2352 by 1568 pixels.
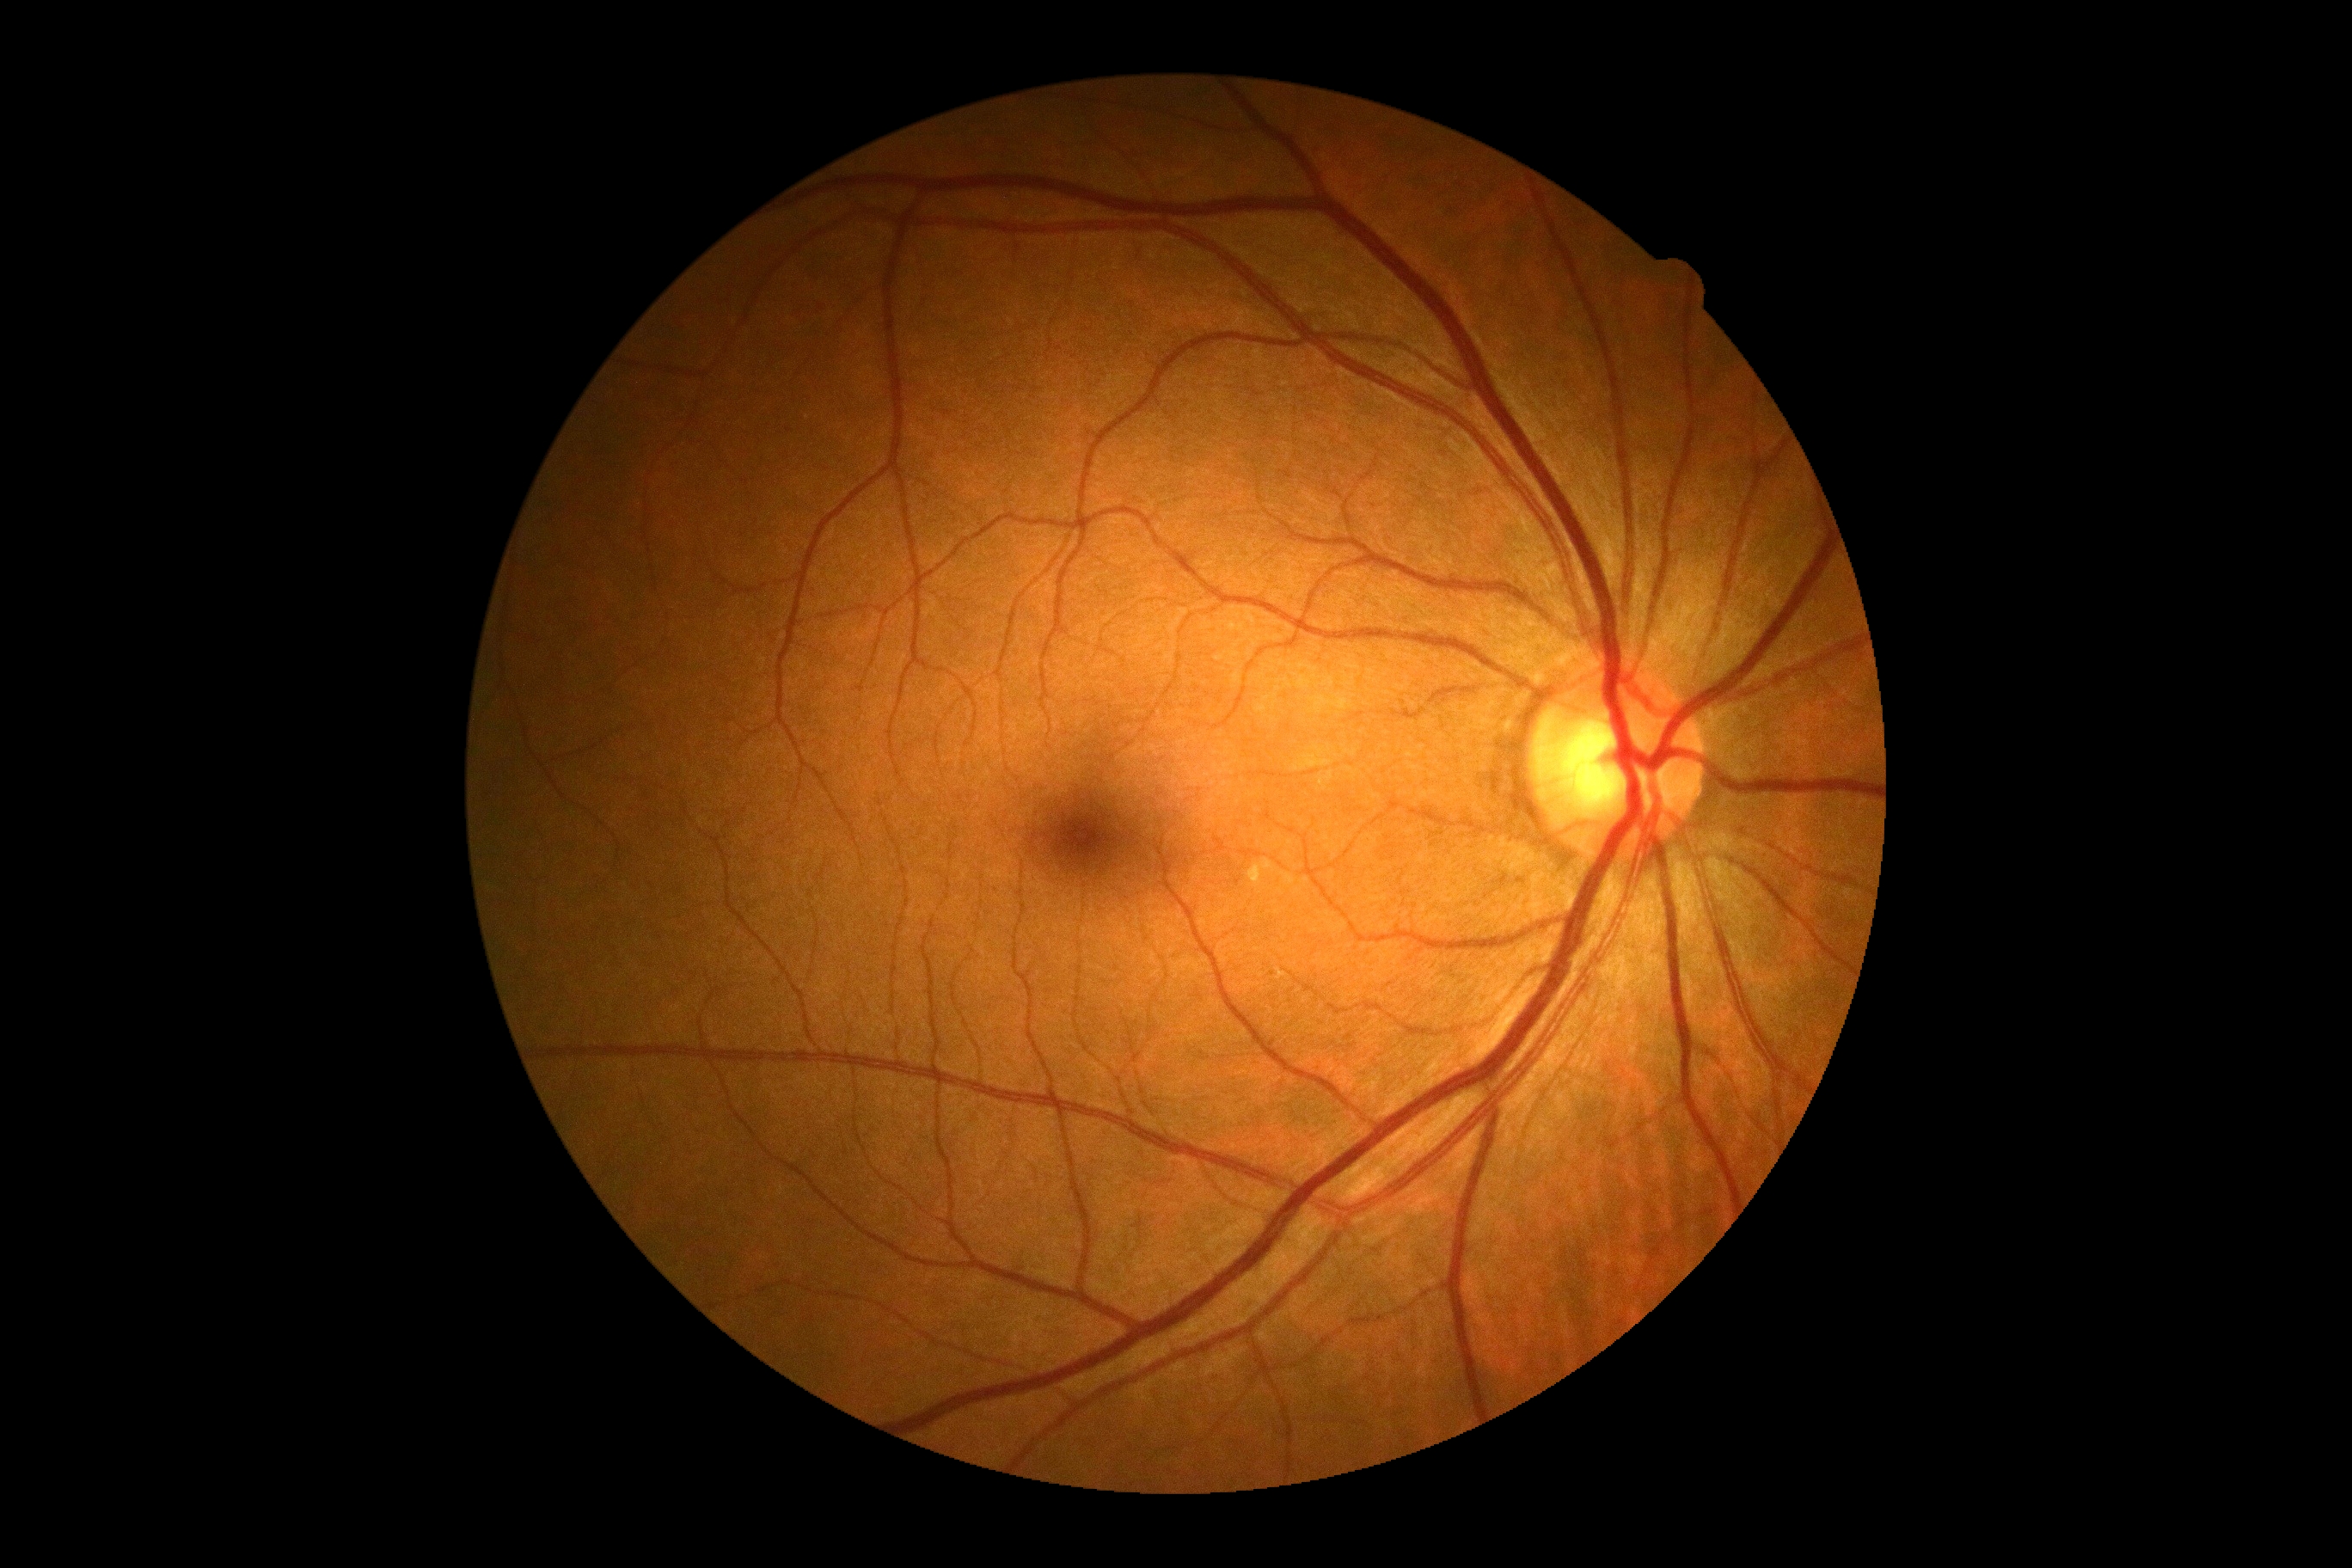

– DR severity — 0/4
– DR impression — negative for DR